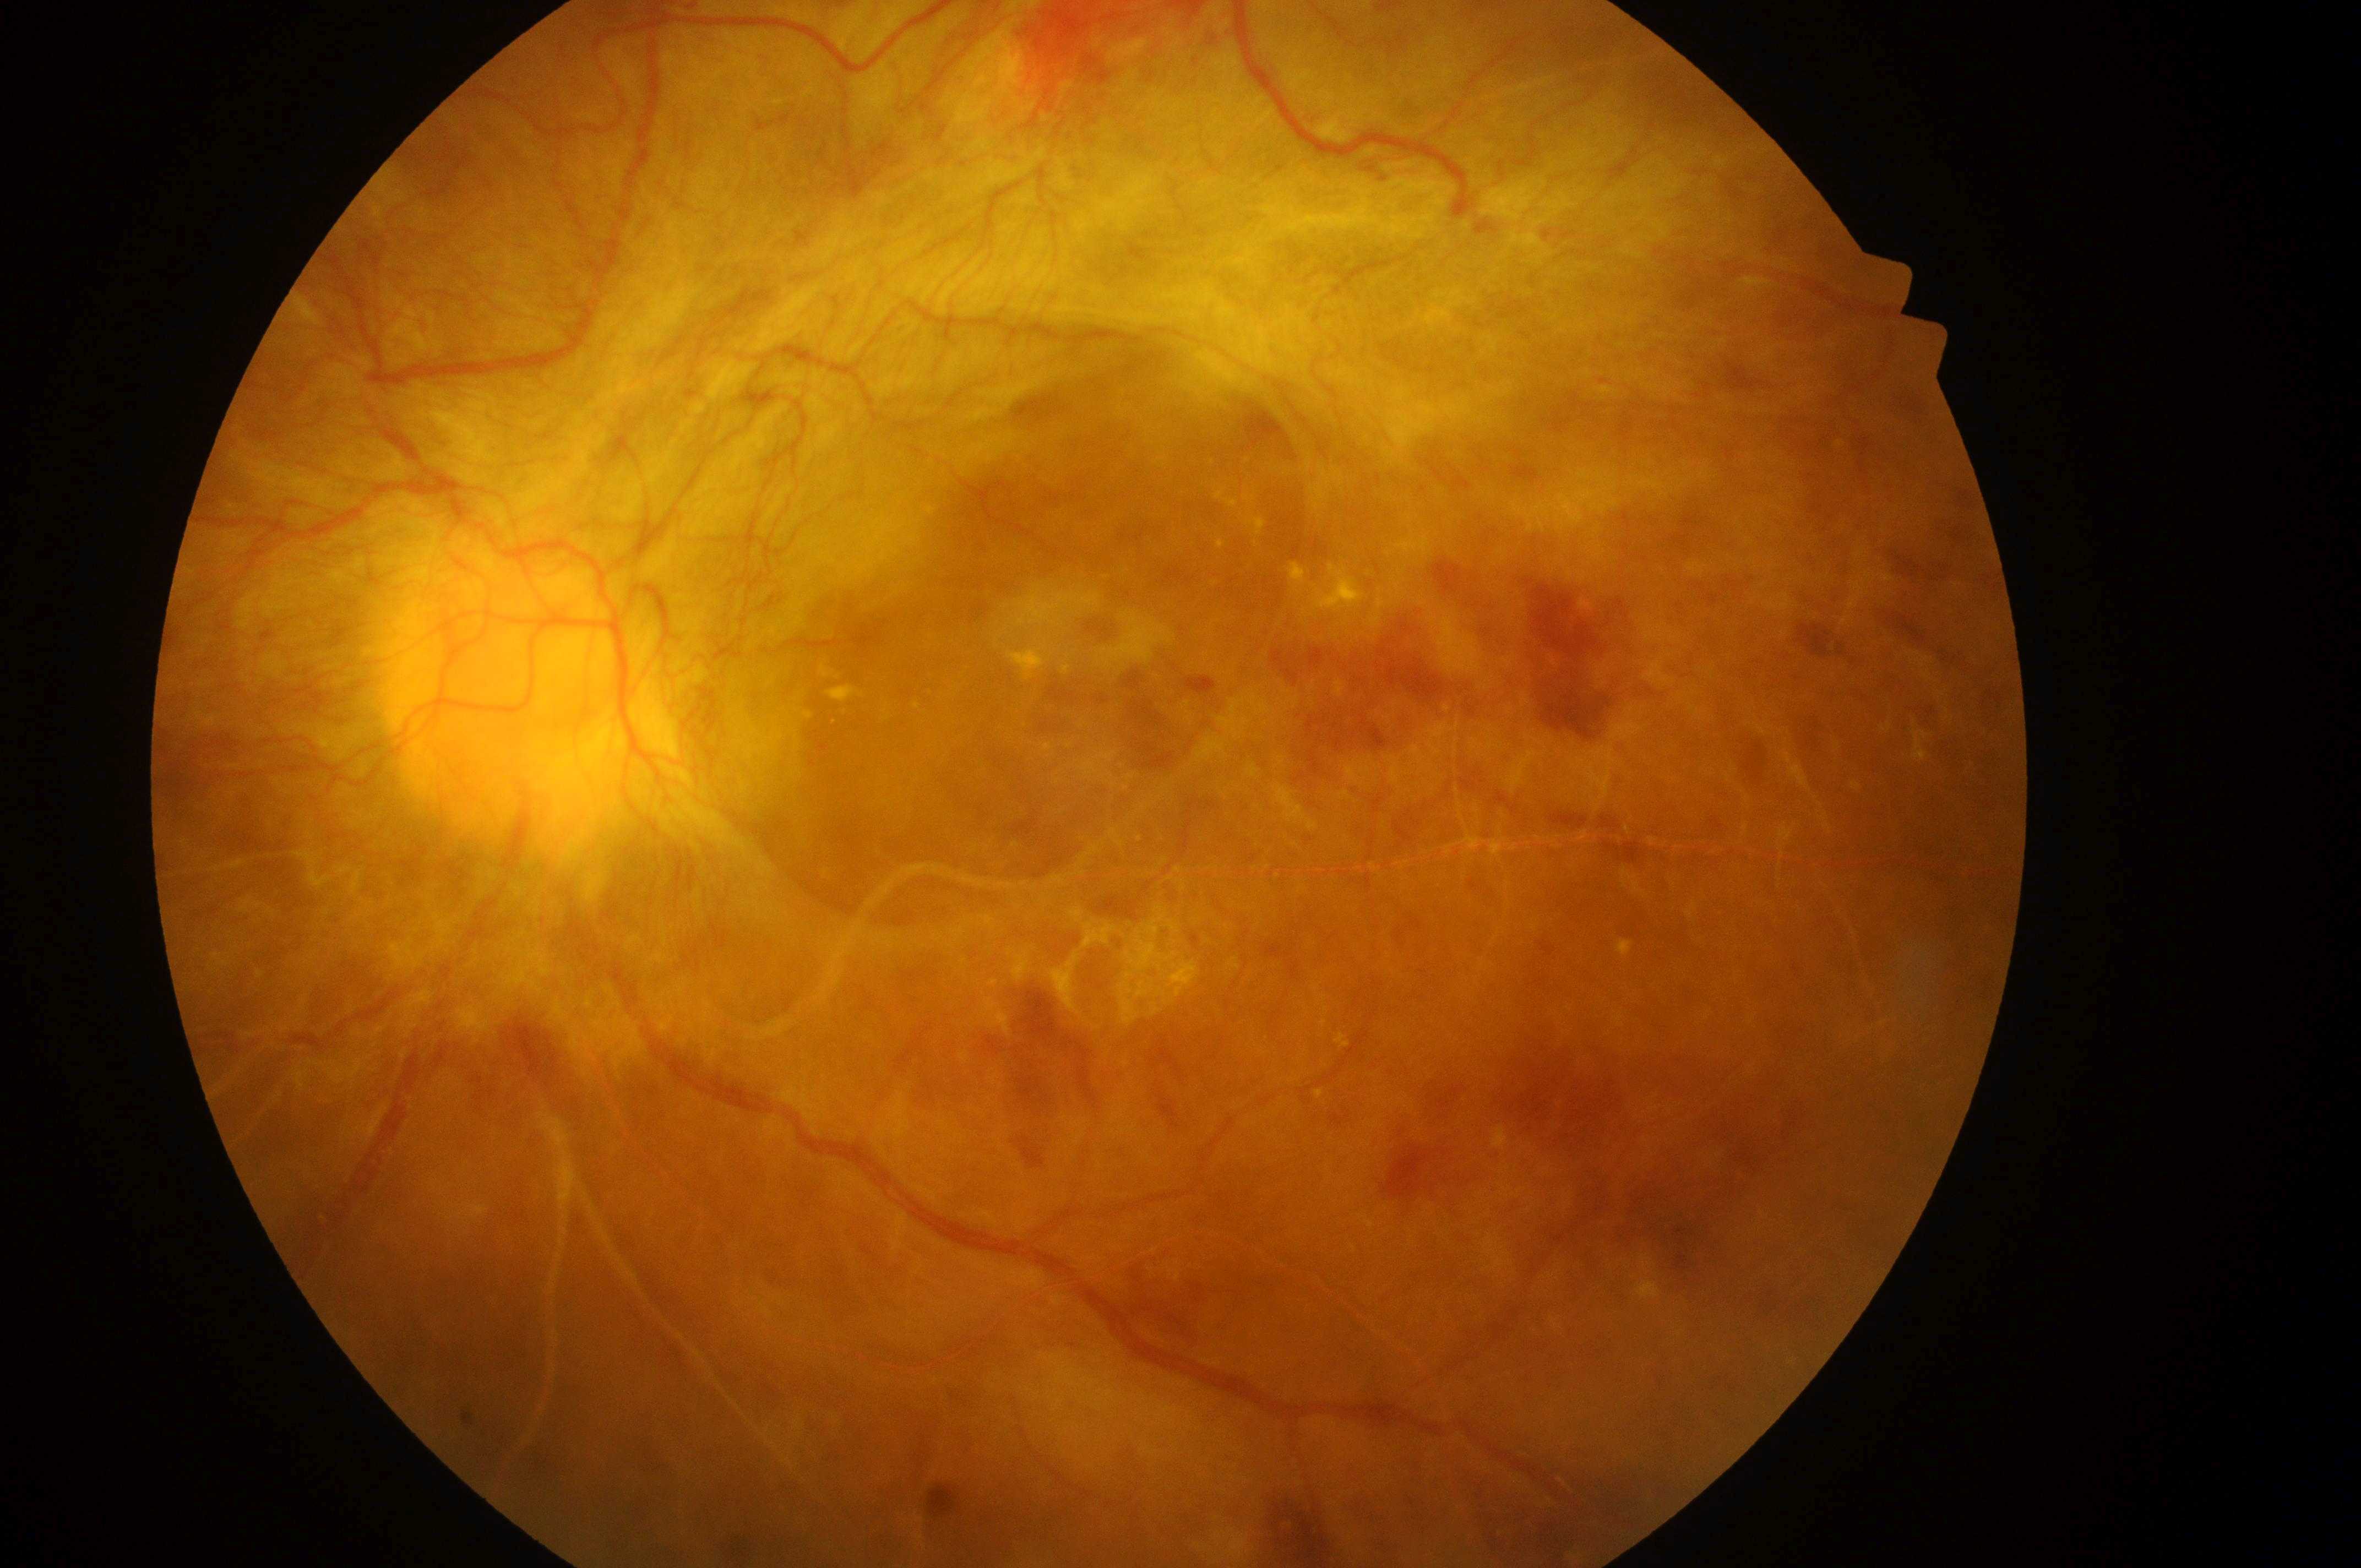
DME: 2.
Disease class: proliferative diabetic retinopathy.
DR stage: 4.
The image shows the left eye.
The optic disc is at (x: 530, y: 696).
Foveal center located at (x: 1114, y: 726).